FOV: 45 degrees; retinal fundus photograph: 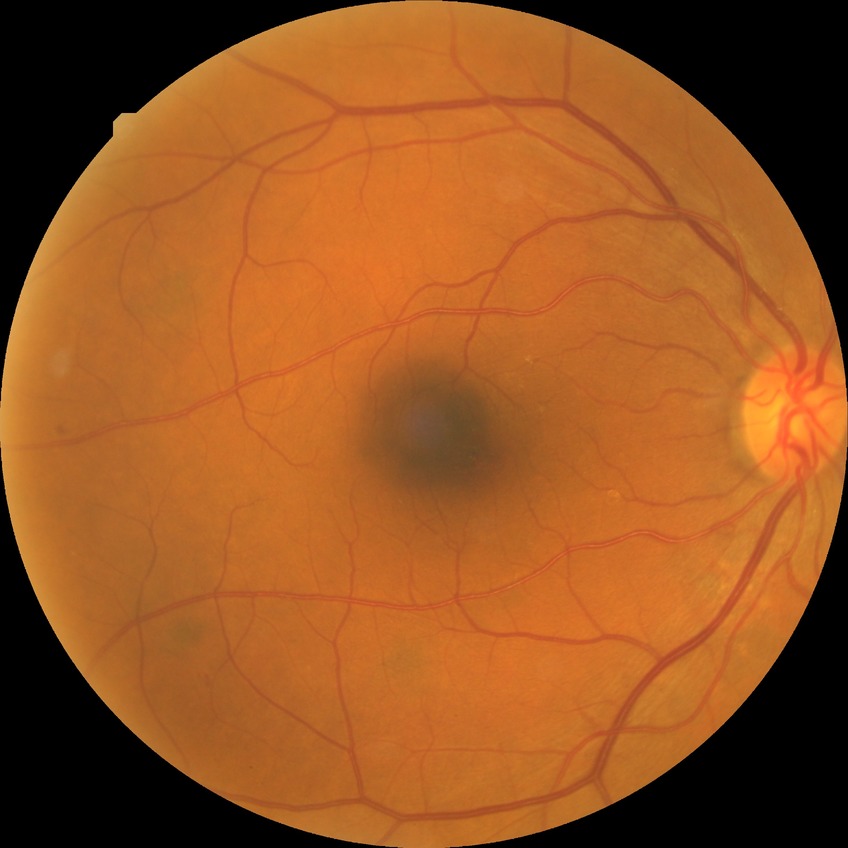 Diabetic retinopathy grade is simple diabetic retinopathy.